2048x1536. Fundus photo — 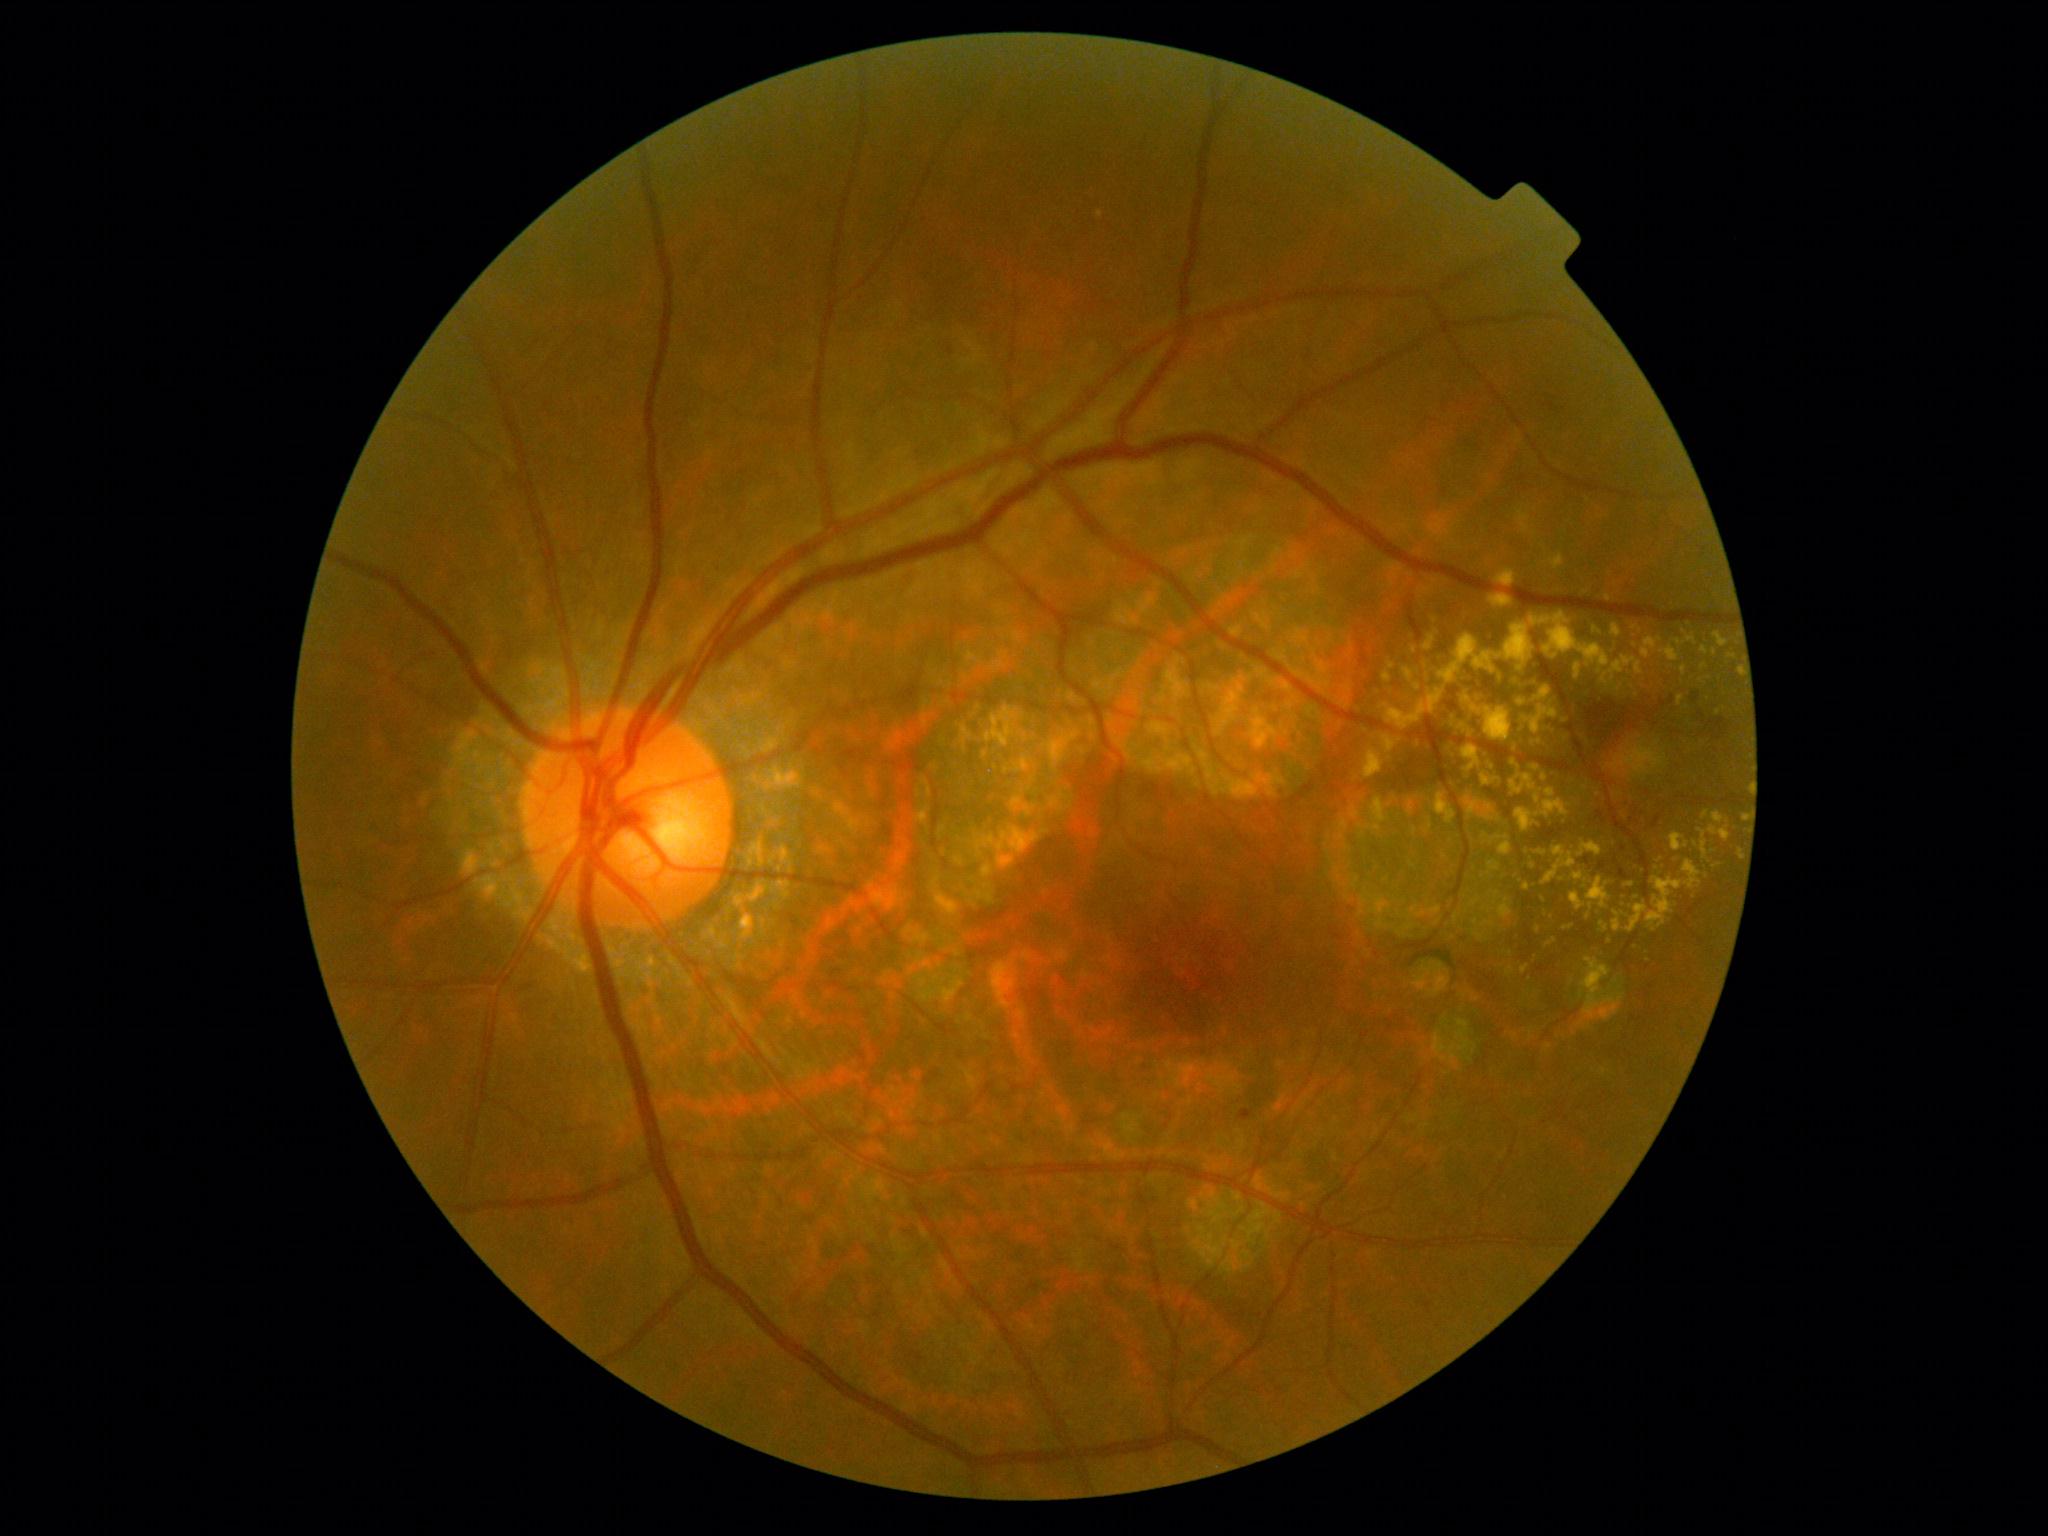

DR: moderate NPDR (grade 2).
EXs are present, including at bbox(1627, 861, 1703, 934); bbox(1482, 773, 1497, 786); bbox(1403, 667, 1420, 684); bbox(1708, 826, 1731, 842); bbox(1490, 836, 1512, 856); bbox(1518, 699, 1528, 707); bbox(1542, 846, 1576, 886); bbox(1508, 679, 1535, 689); bbox(1728, 654, 1737, 660); bbox(1681, 666, 1687, 677); bbox(1546, 938, 1558, 948); bbox(1564, 925, 1574, 931); bbox(1434, 793, 1456, 825).
Additional small EXs near <point>1598, 795</point>; <point>1426, 667</point>; <point>1492, 768</point>; <point>1704, 667</point>; <point>1715, 867</point>; <point>1610, 942</point>; <point>1635, 628</point>.